FOV: 45 degrees: 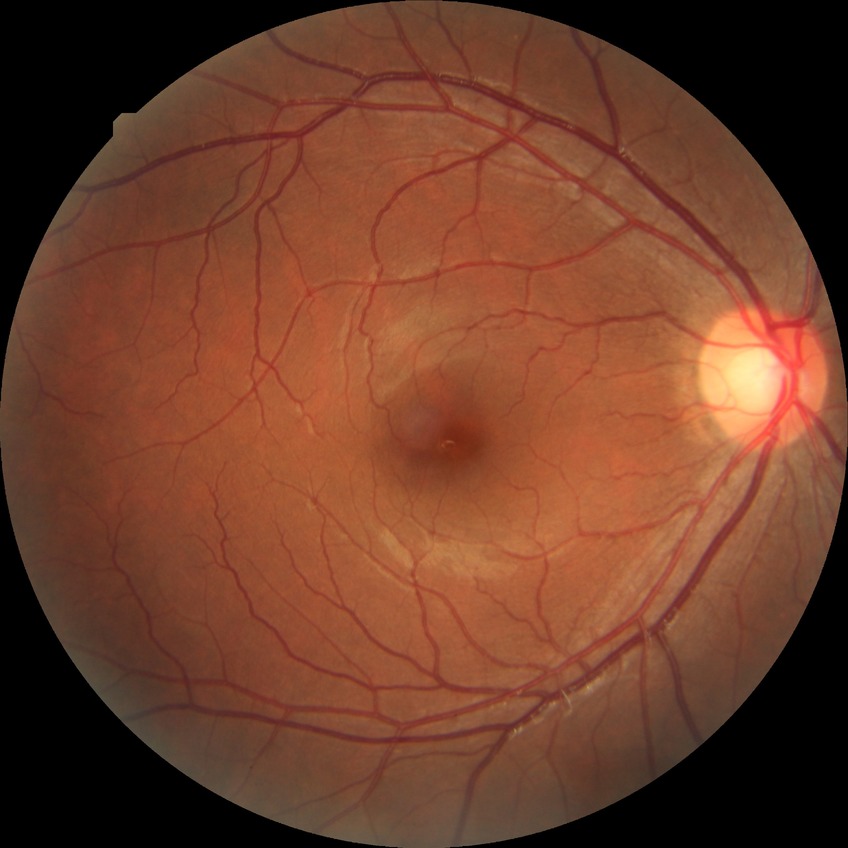
Annotations:
* diabetic retinopathy (DR) — NDR (no diabetic retinopathy)